FOV: 45 degrees, color fundus photograph.
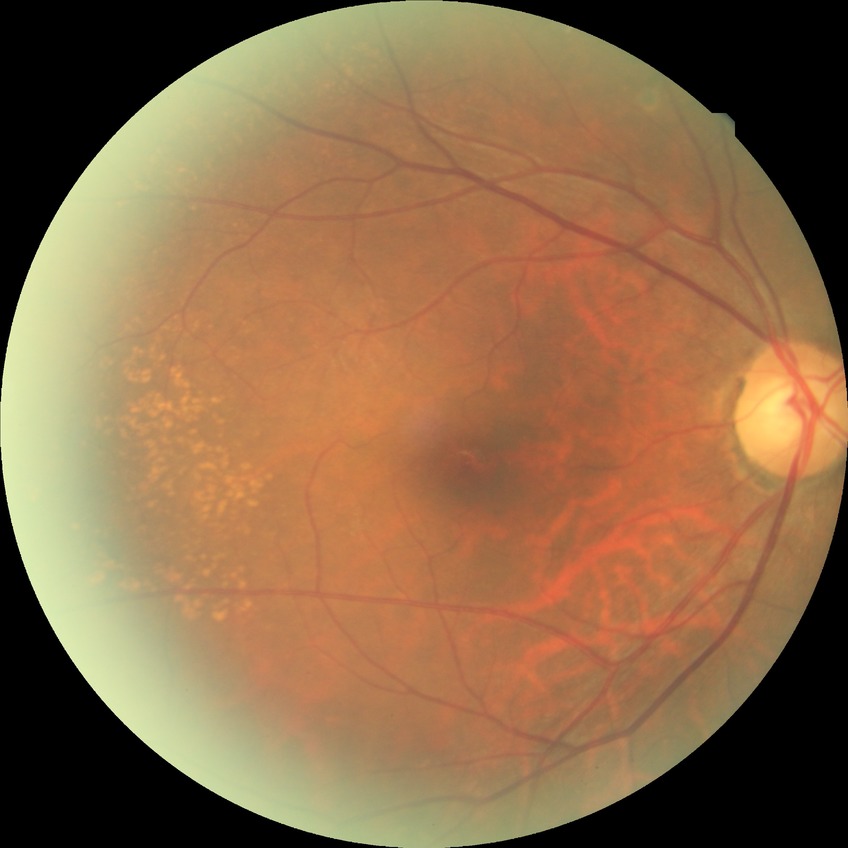
davis_grade: NDR (no diabetic retinopathy)